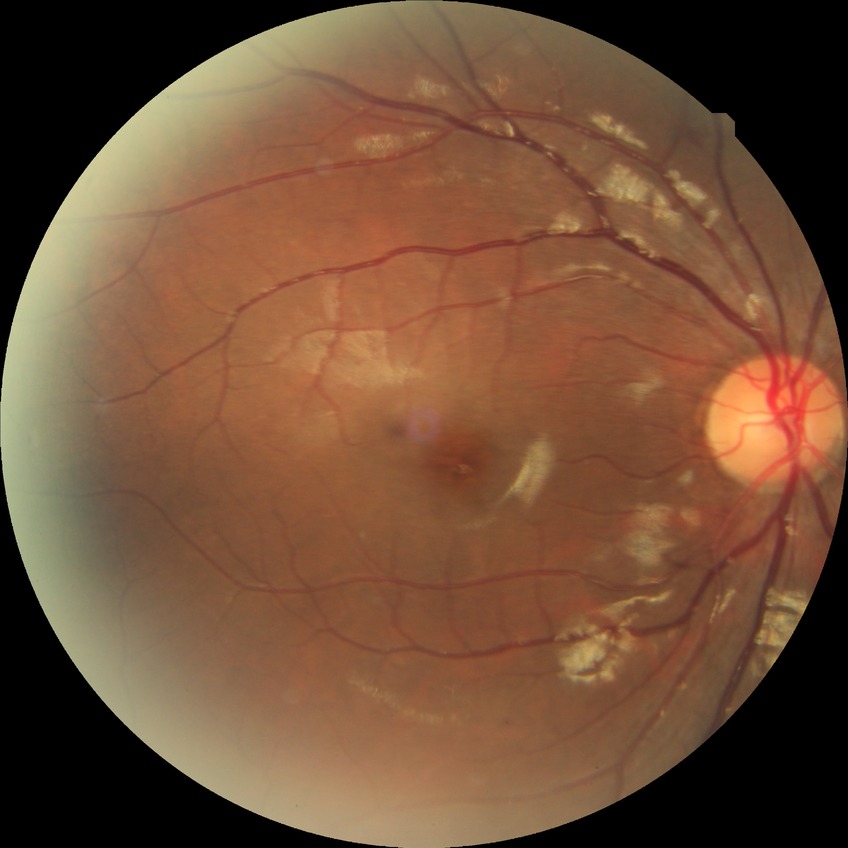

modified Davis grading: no diabetic retinopathy.